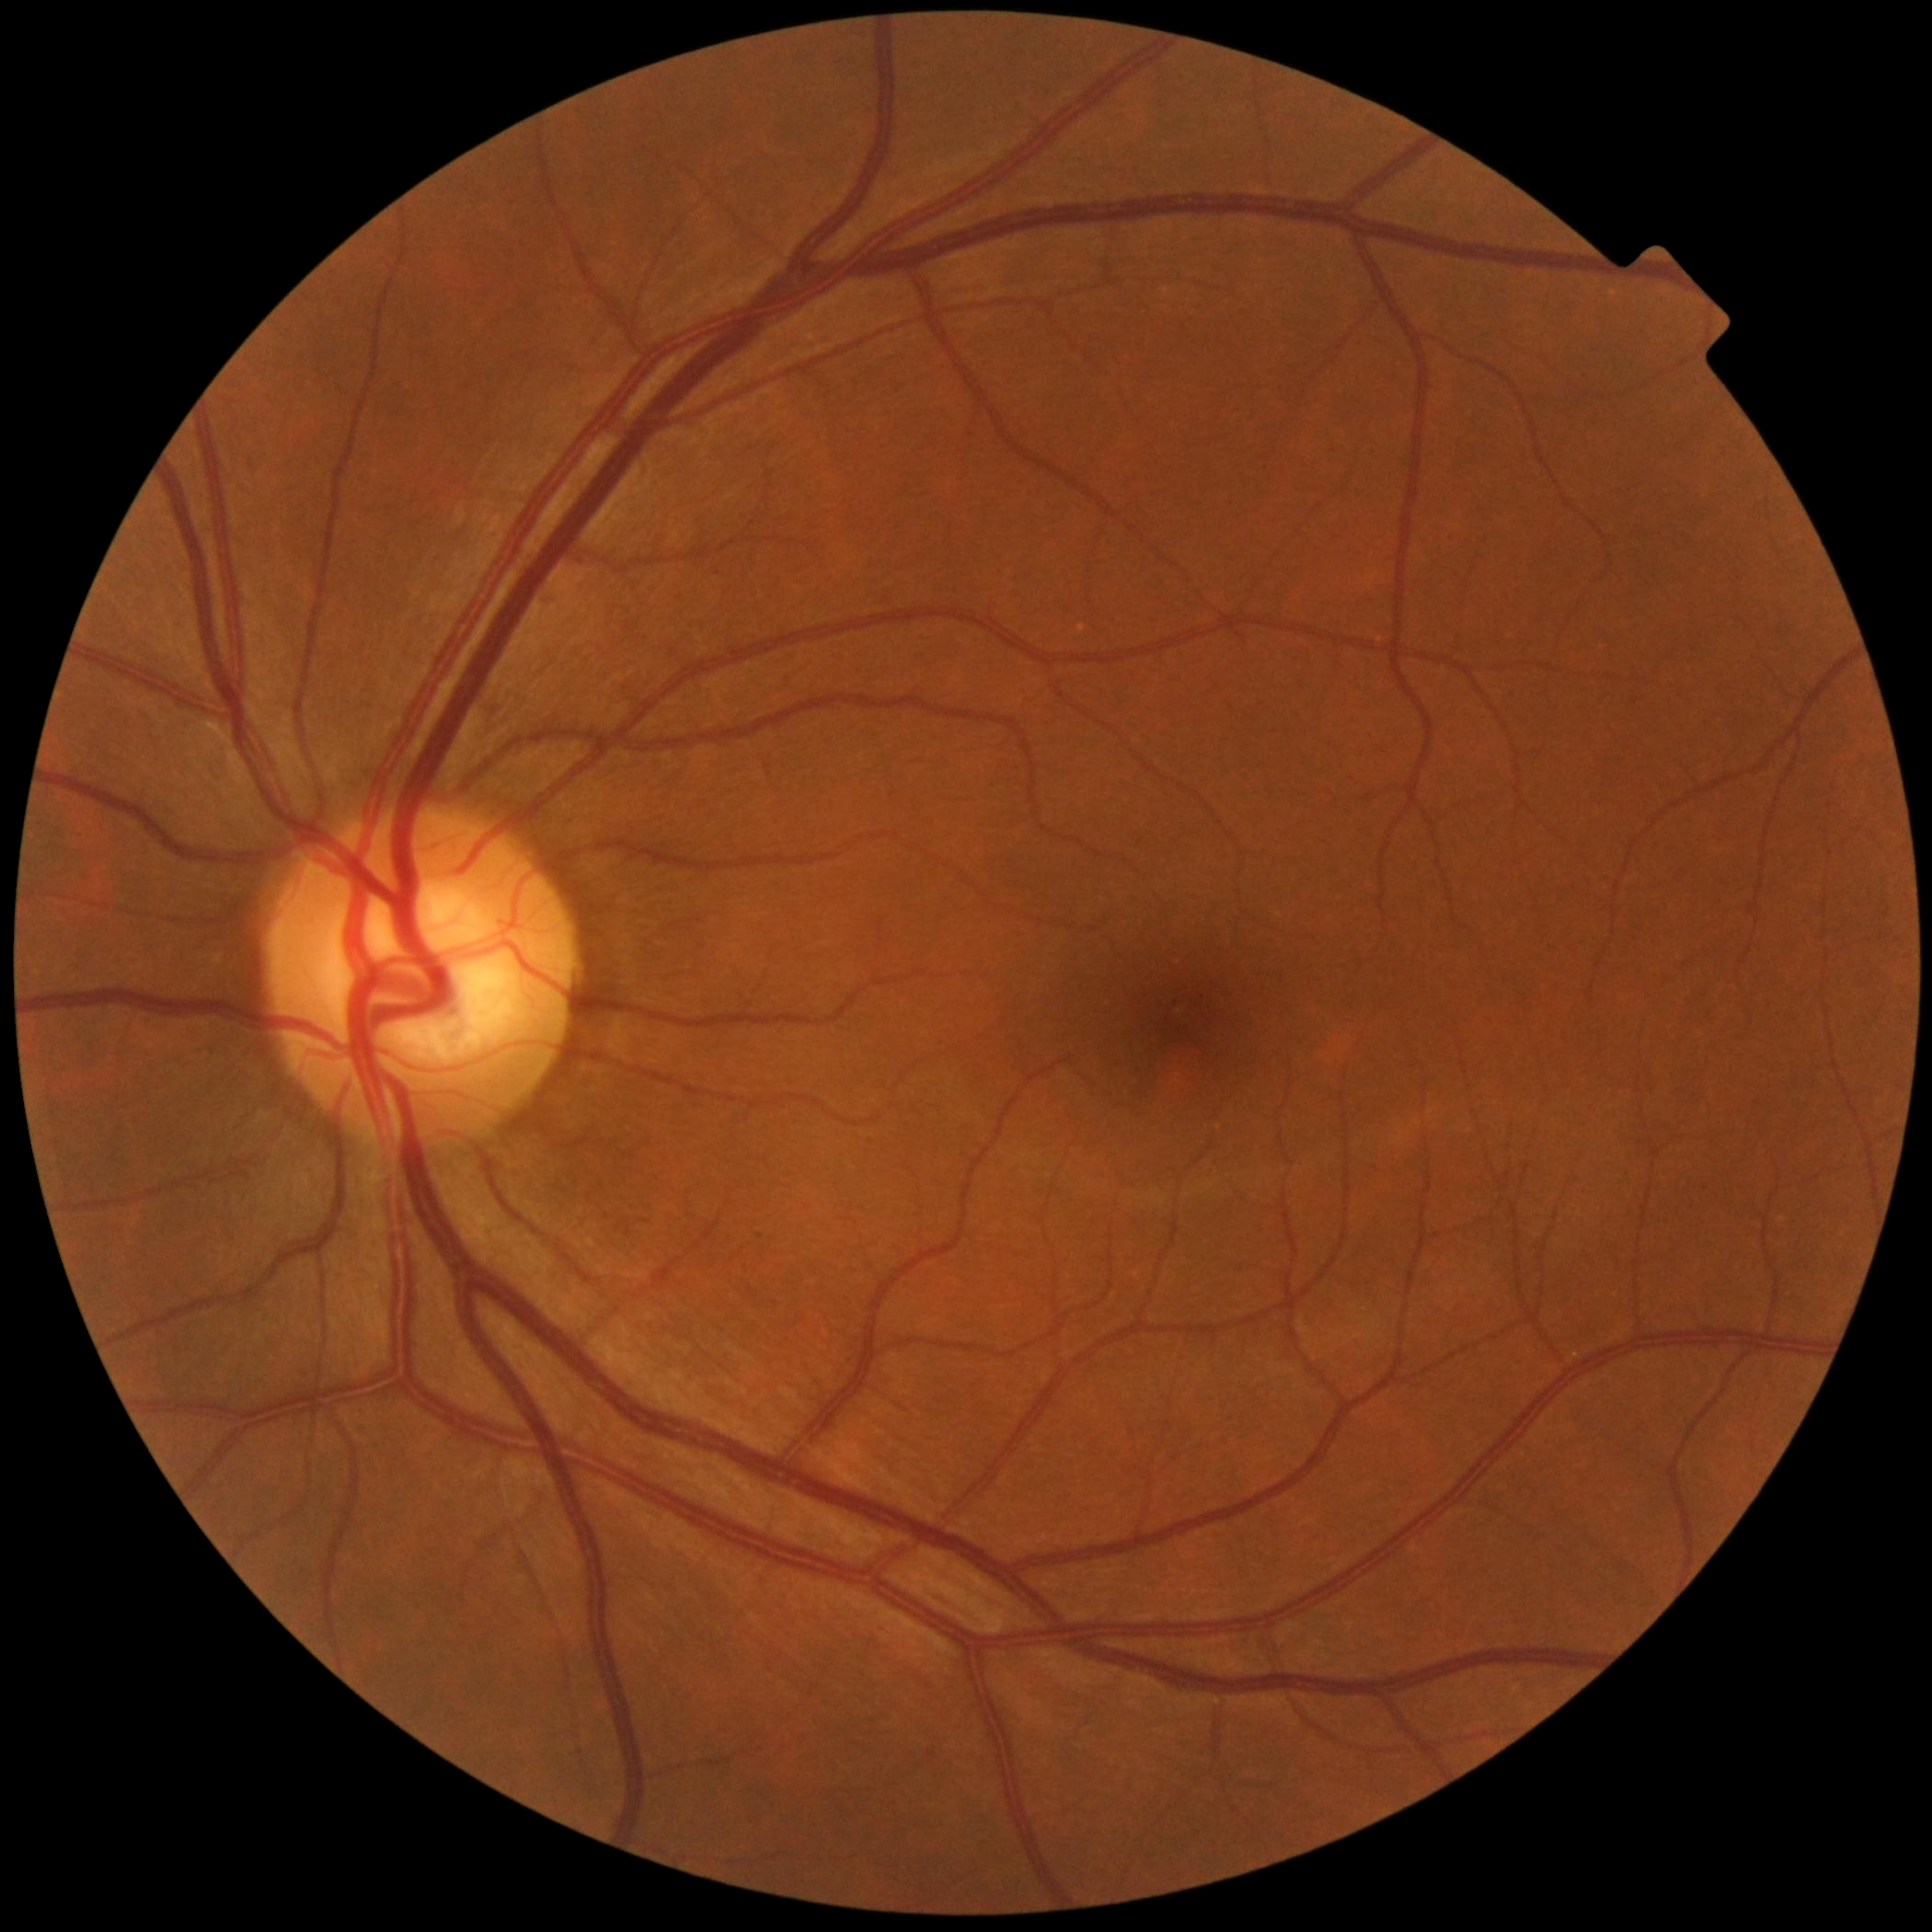 Diabetic retinopathy: 0/4 — no visible signs of diabetic retinopathy.